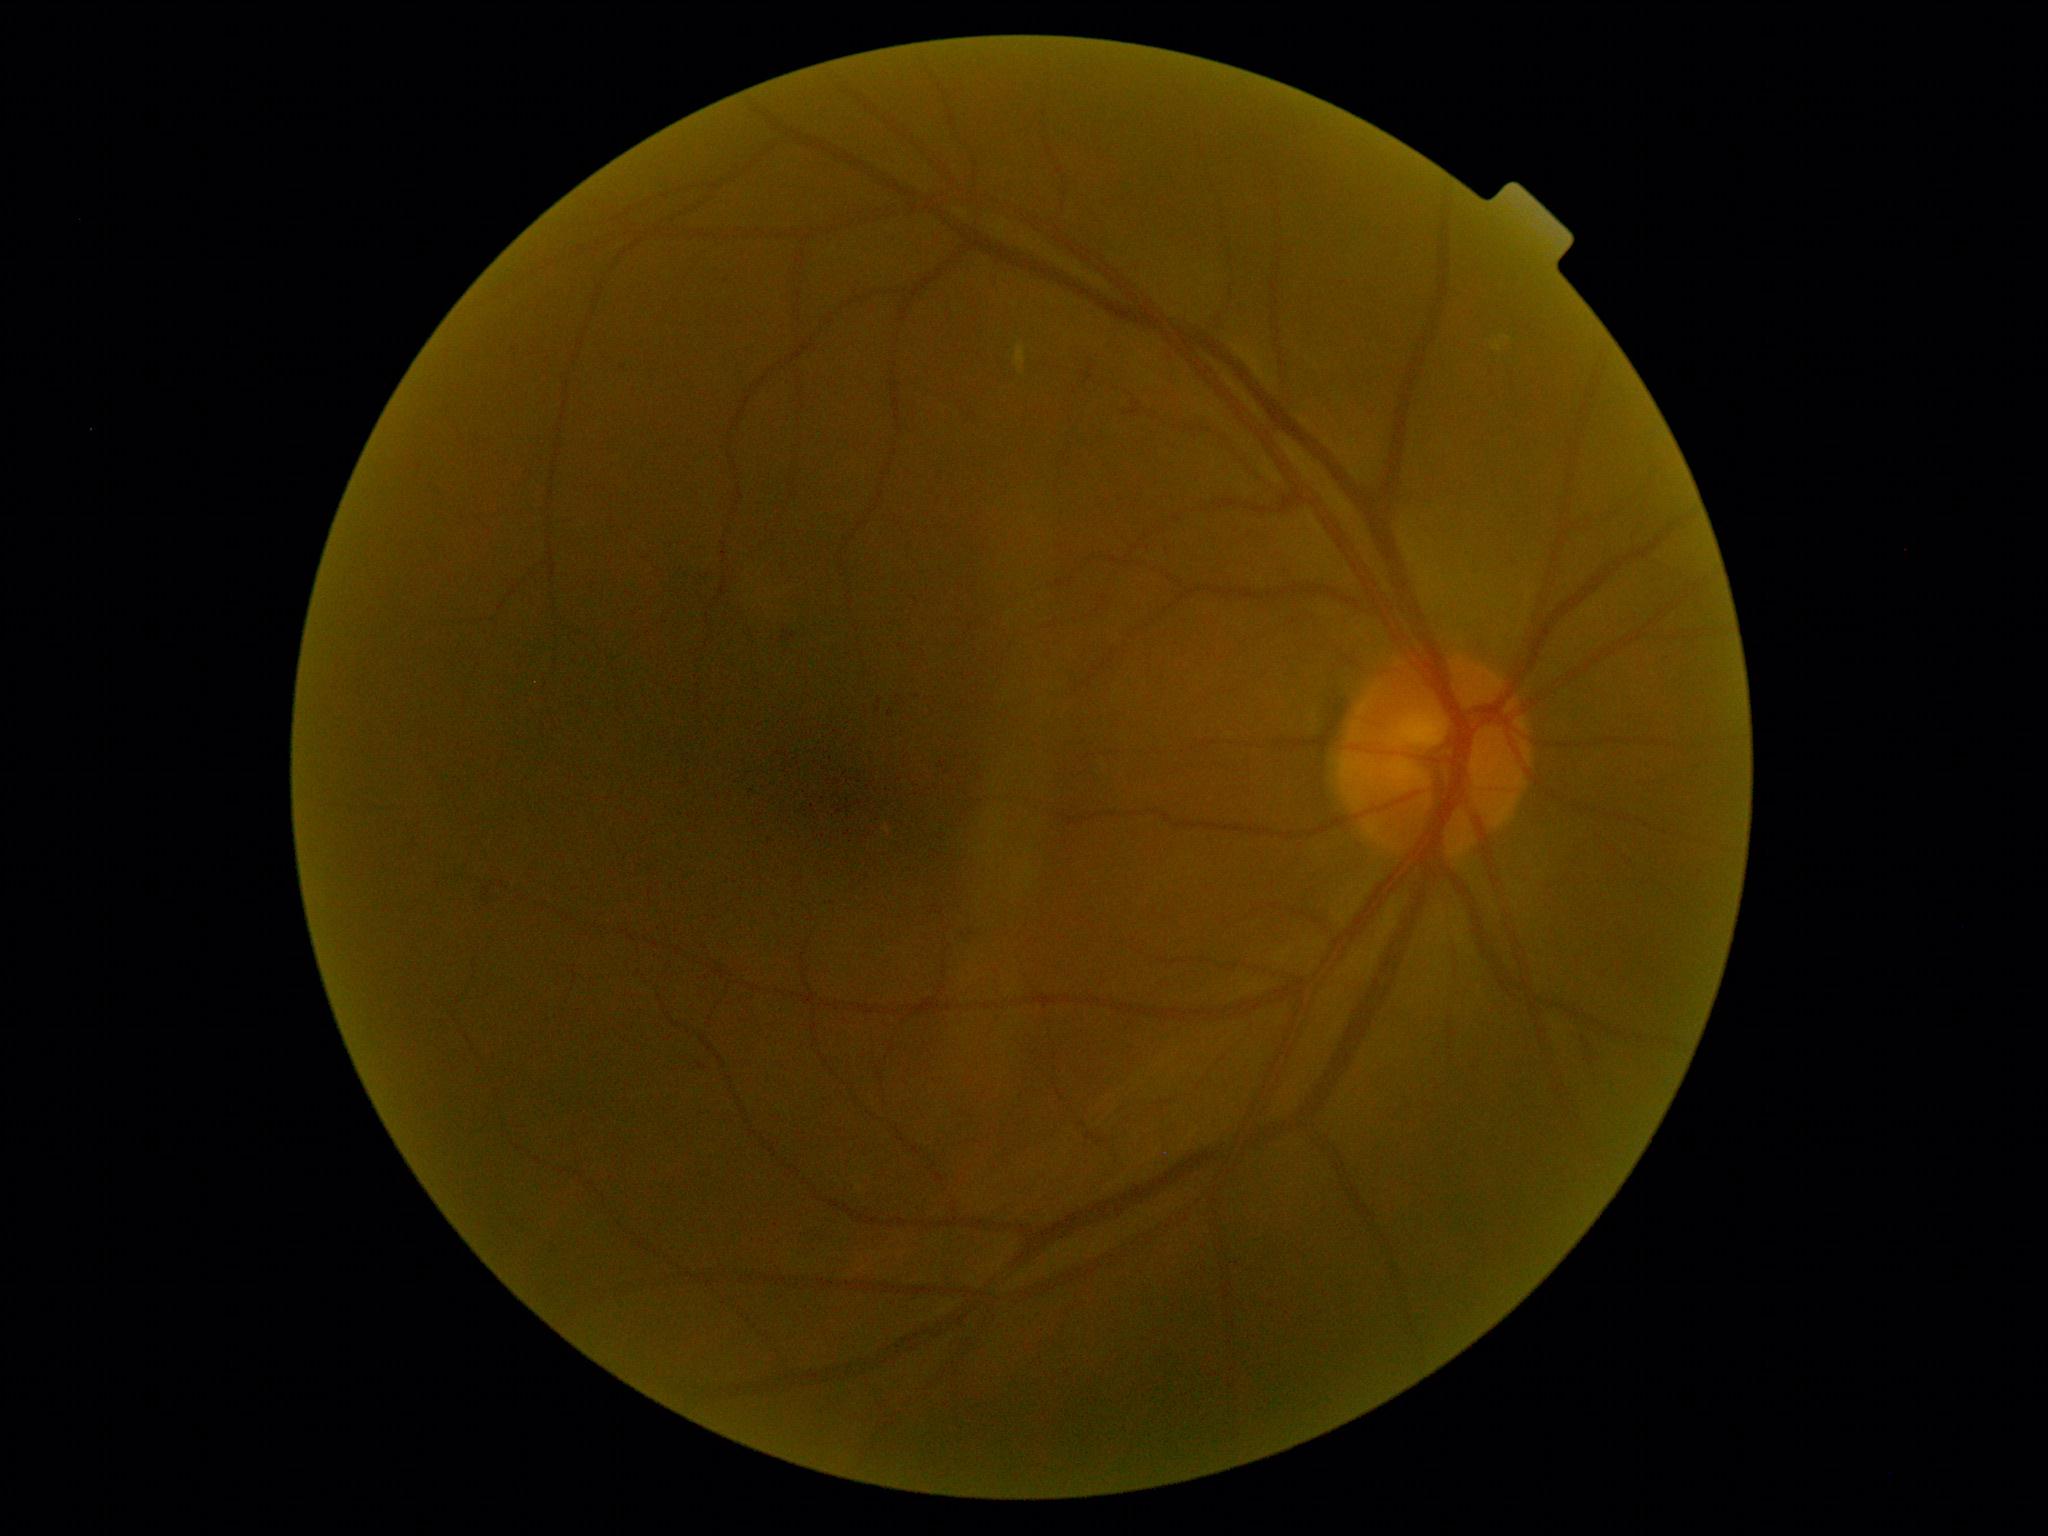
diabetic retinopathy (DR) = moderate NPDR (grade 2).